Posterior pole photograph. 848 by 848 pixels: 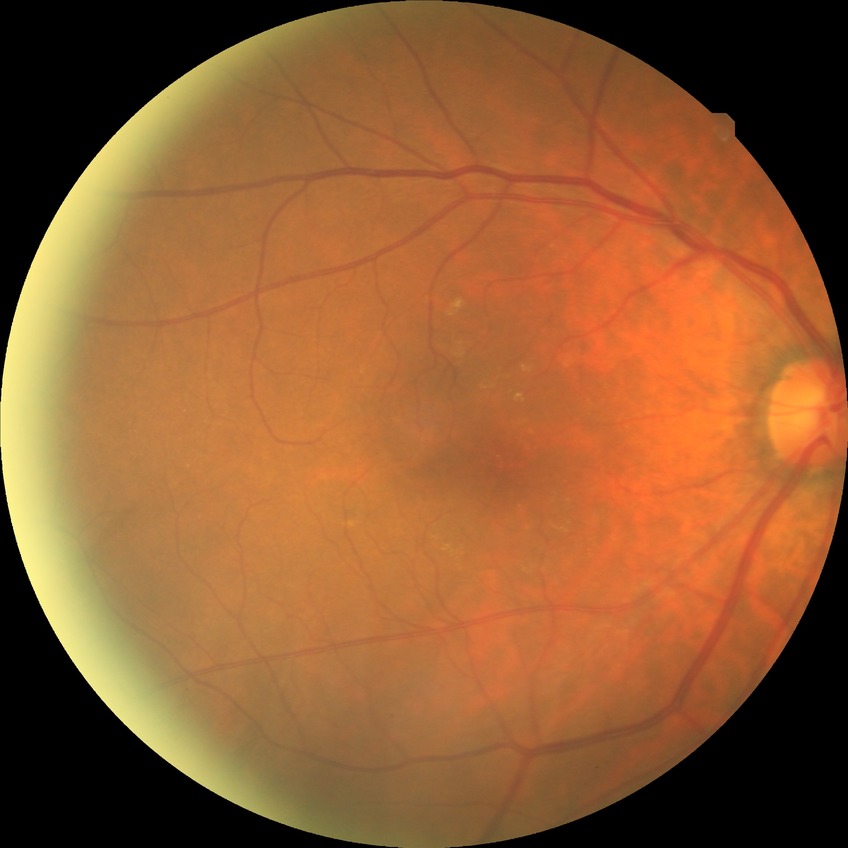 * Davis grading — no diabetic retinopathy